1240x1240. 100° field of view (Phoenix ICON). Wide-field fundus photograph from neonatal ROP screening.
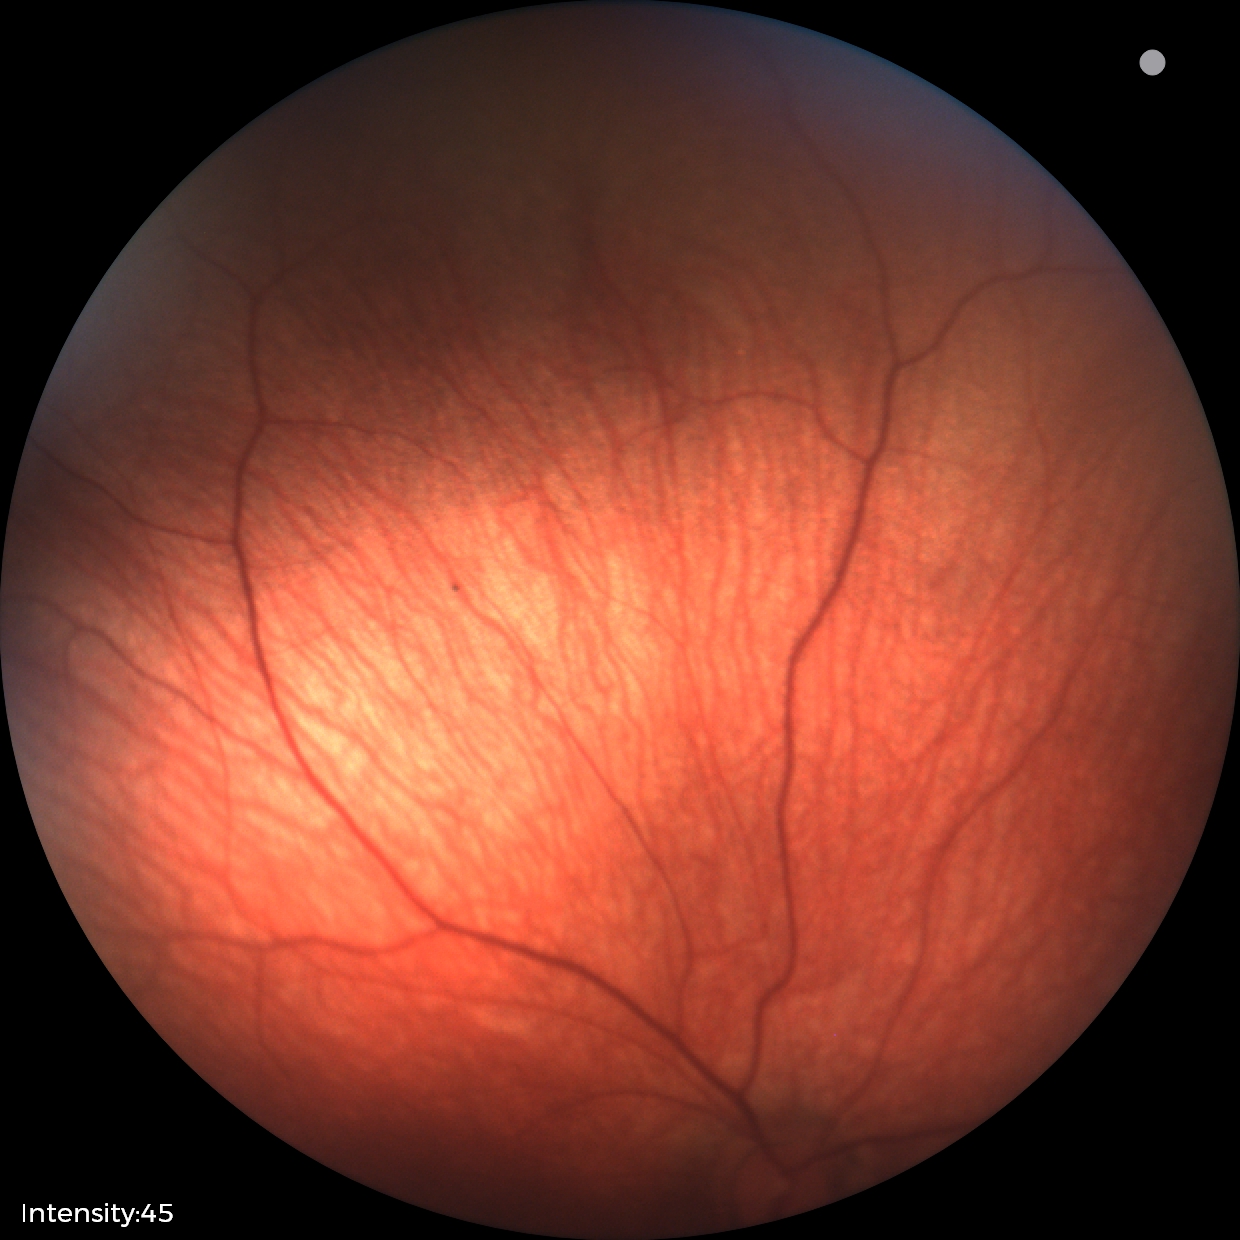 Screening diagnosis: normal